Posterior pole photograph, nonmydriatic — 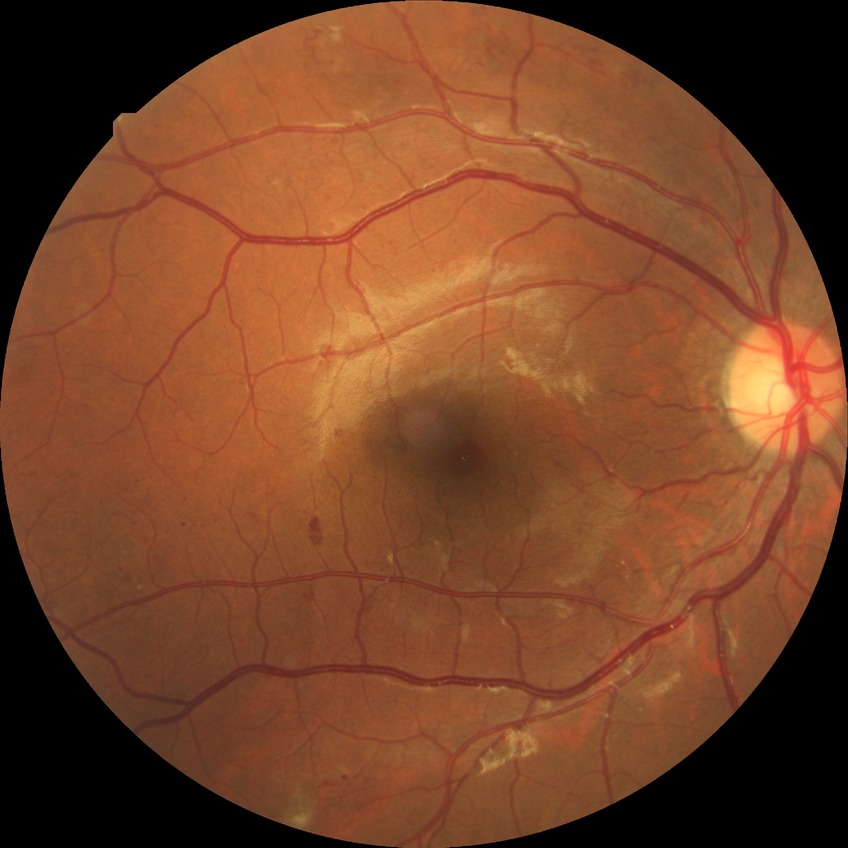

diabetic retinopathy (DR) = pre-proliferative diabetic retinopathy (PPDR)
DR class = non-proliferative diabetic retinopathy